Clarity RetCam 3, 130° FOV. RetCam wide-field infant fundus image — 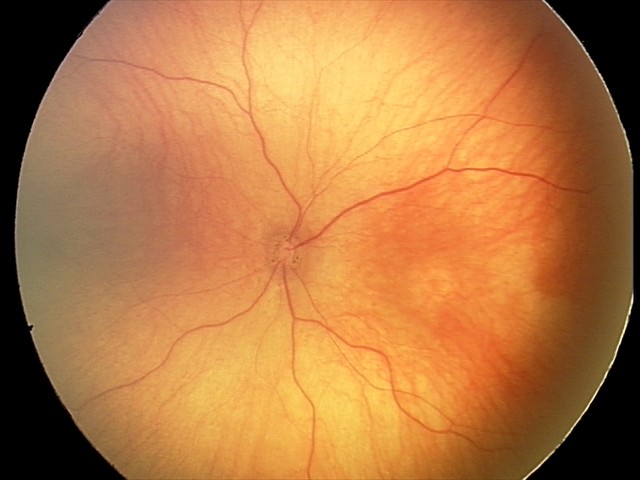 Q: What was the screening finding?
A: normal retinal appearance